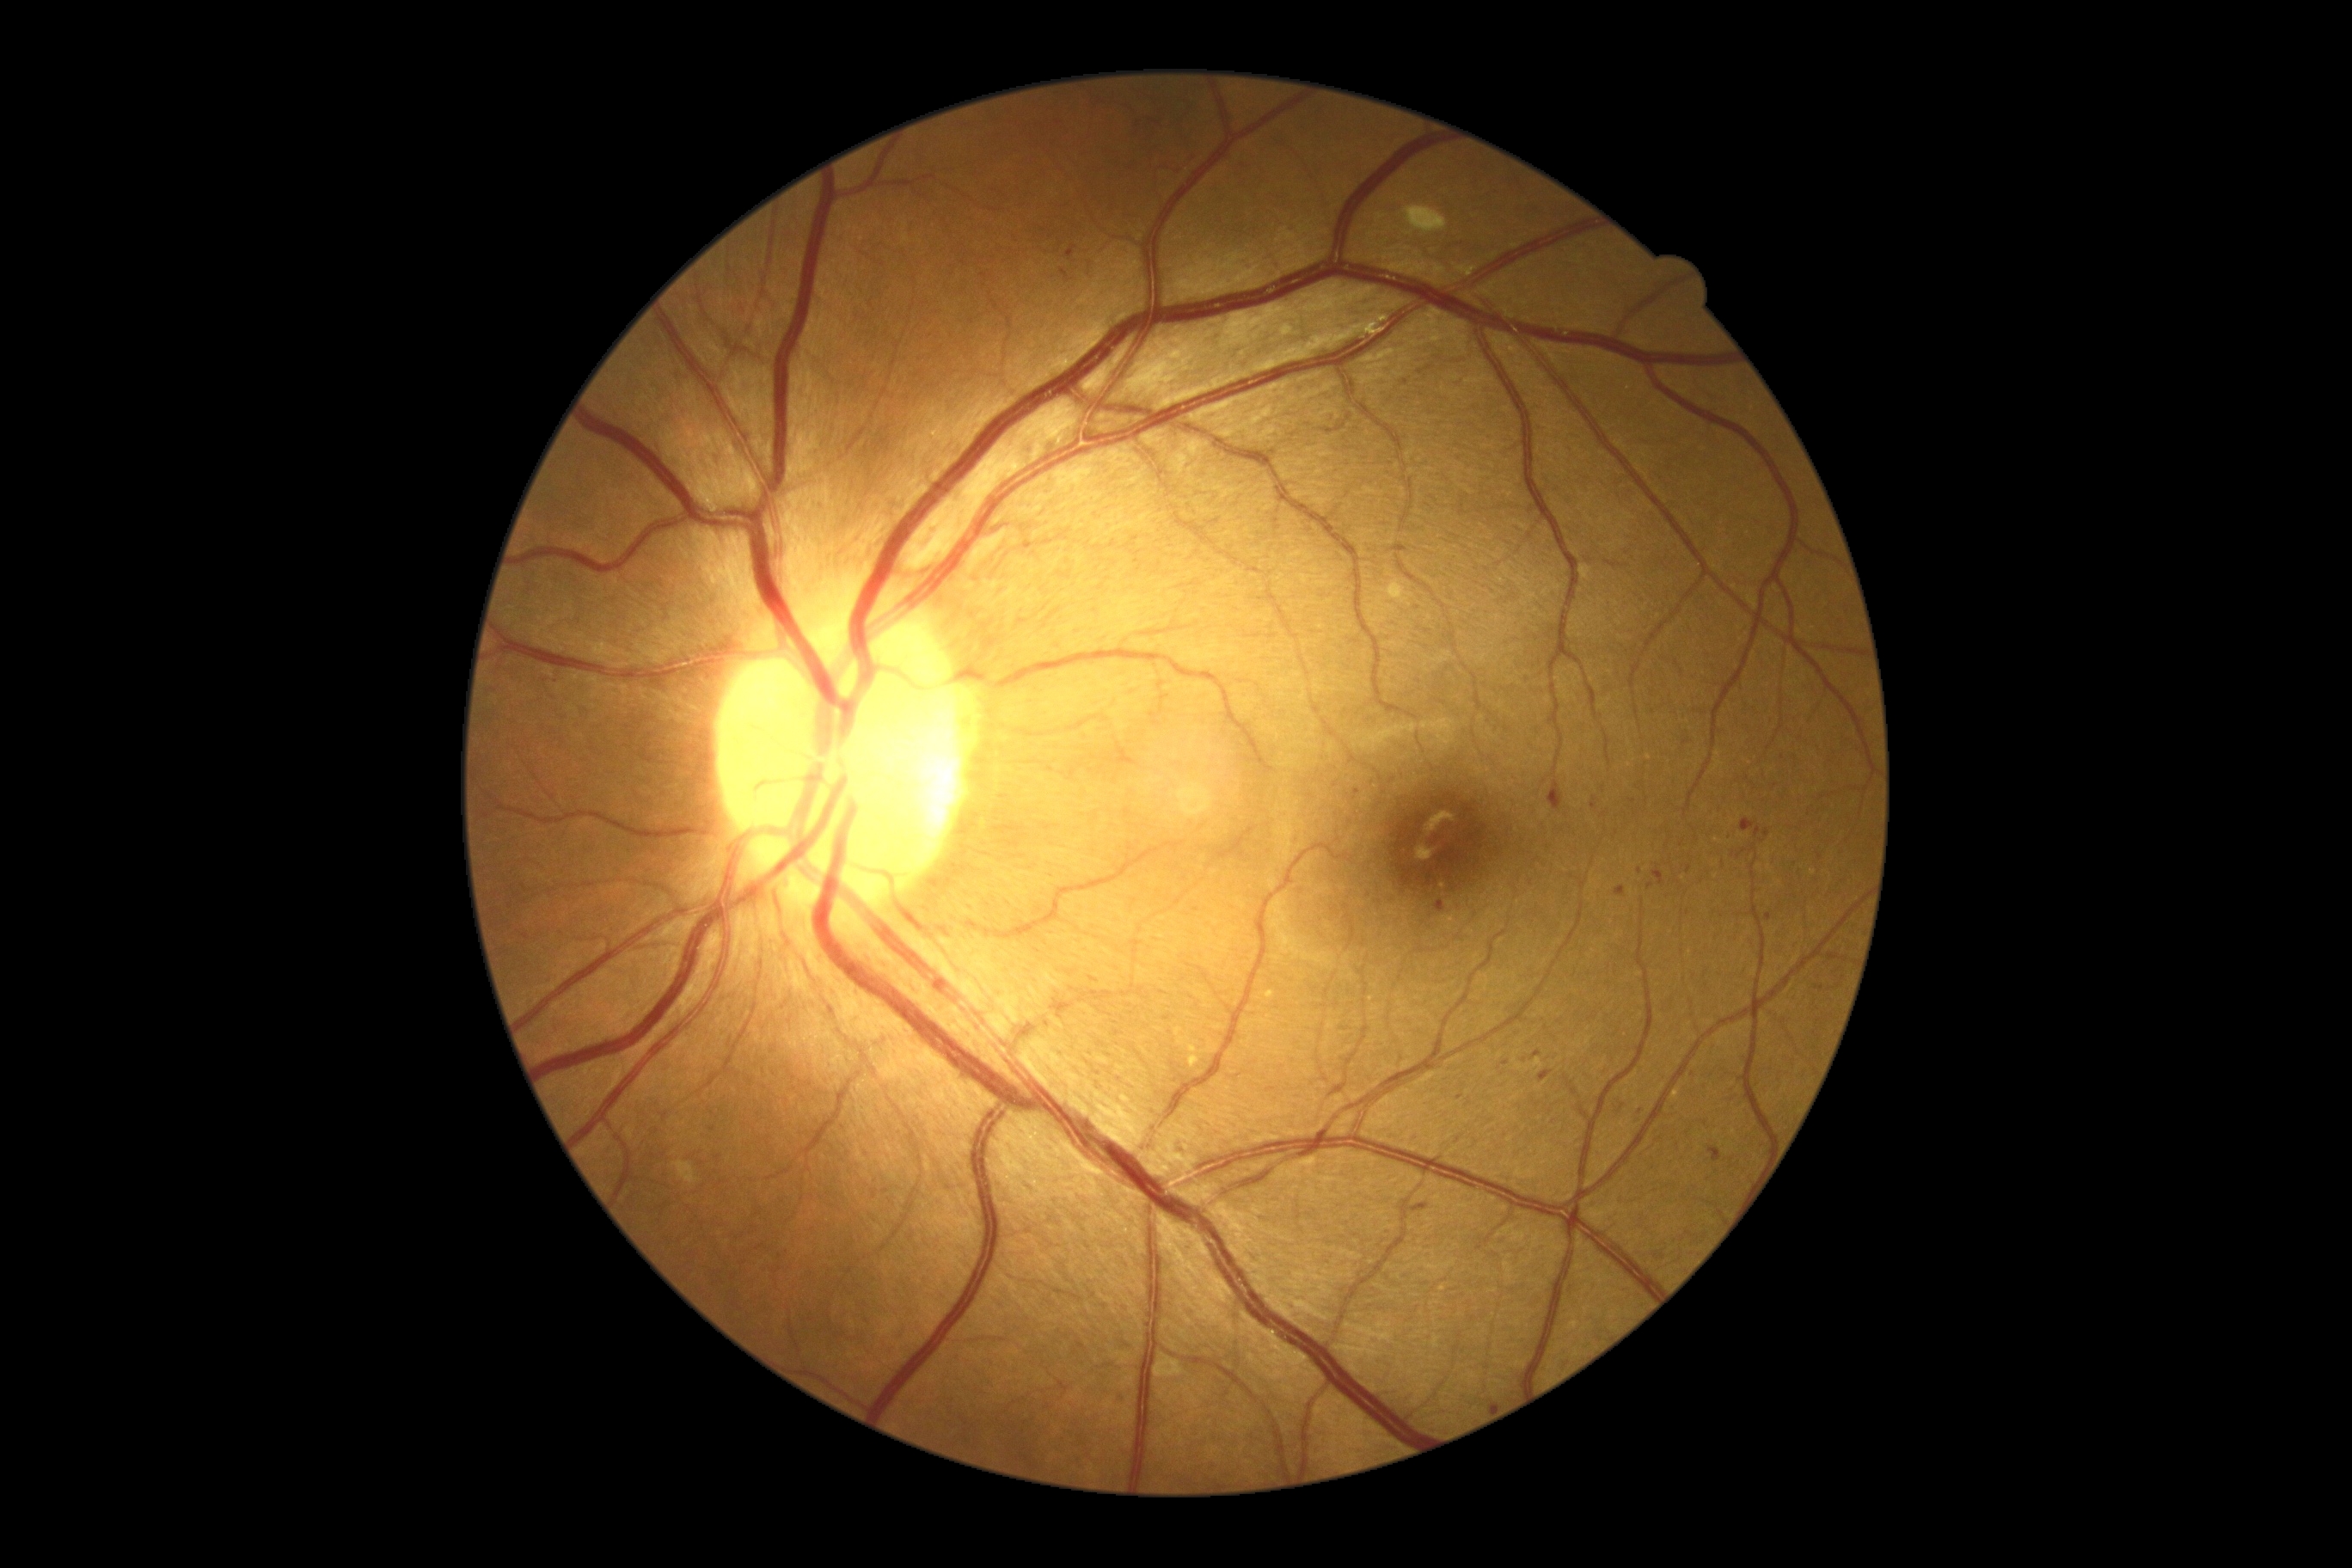 Diabetic retinopathy (DR) is 2/4
Selected lesions:
hemorrhages (HEs) (continued) = (left=1629, top=800, right=1638, bottom=804), (left=1624, top=329, right=1631, bottom=338), (left=1538, top=1070, right=1553, bottom=1084), (left=771, top=1268, right=781, bottom=1275), (left=1411, top=1203, right=1428, bottom=1216), (left=1682, top=740, right=1691, bottom=745), (left=1063, top=248, right=1075, bottom=260), (left=1615, top=886, right=1626, bottom=897), (left=1765, top=914, right=1772, bottom=922), (left=1591, top=797, right=1598, bottom=811), (left=1650, top=1246, right=1667, bottom=1263), (left=1632, top=1108, right=1645, bottom=1124)
Small HEs approximately at (1776,785), (1059,123), (1524,1060), (1706,1125)